Graded on the modified Davis scale.
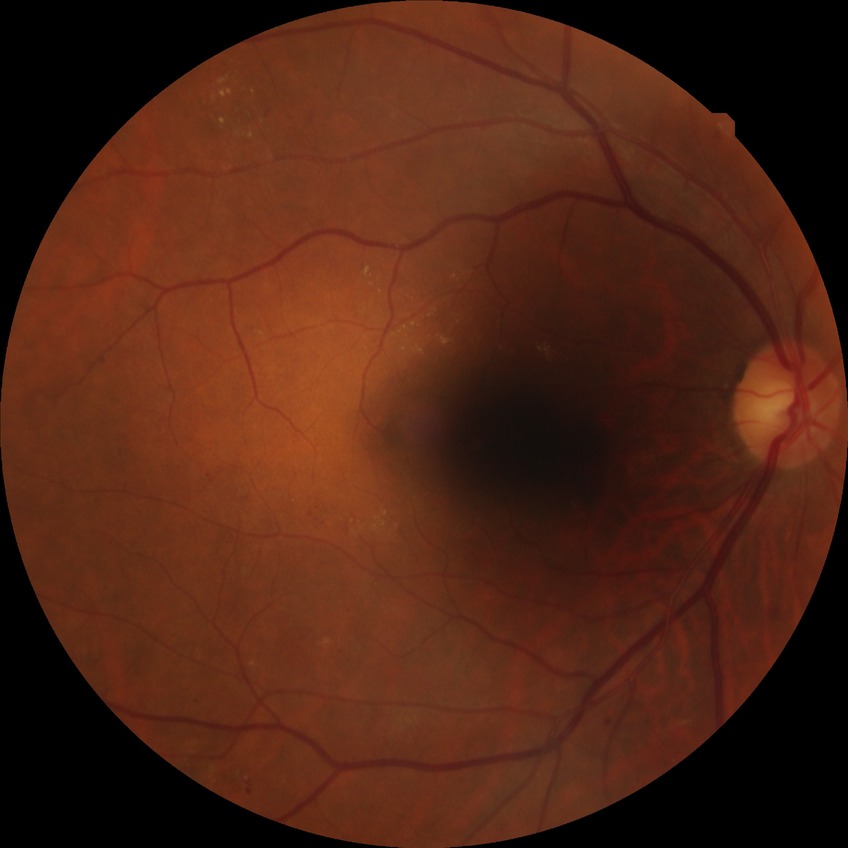
davis_grade: simple diabetic retinopathy